45-degree field of view.
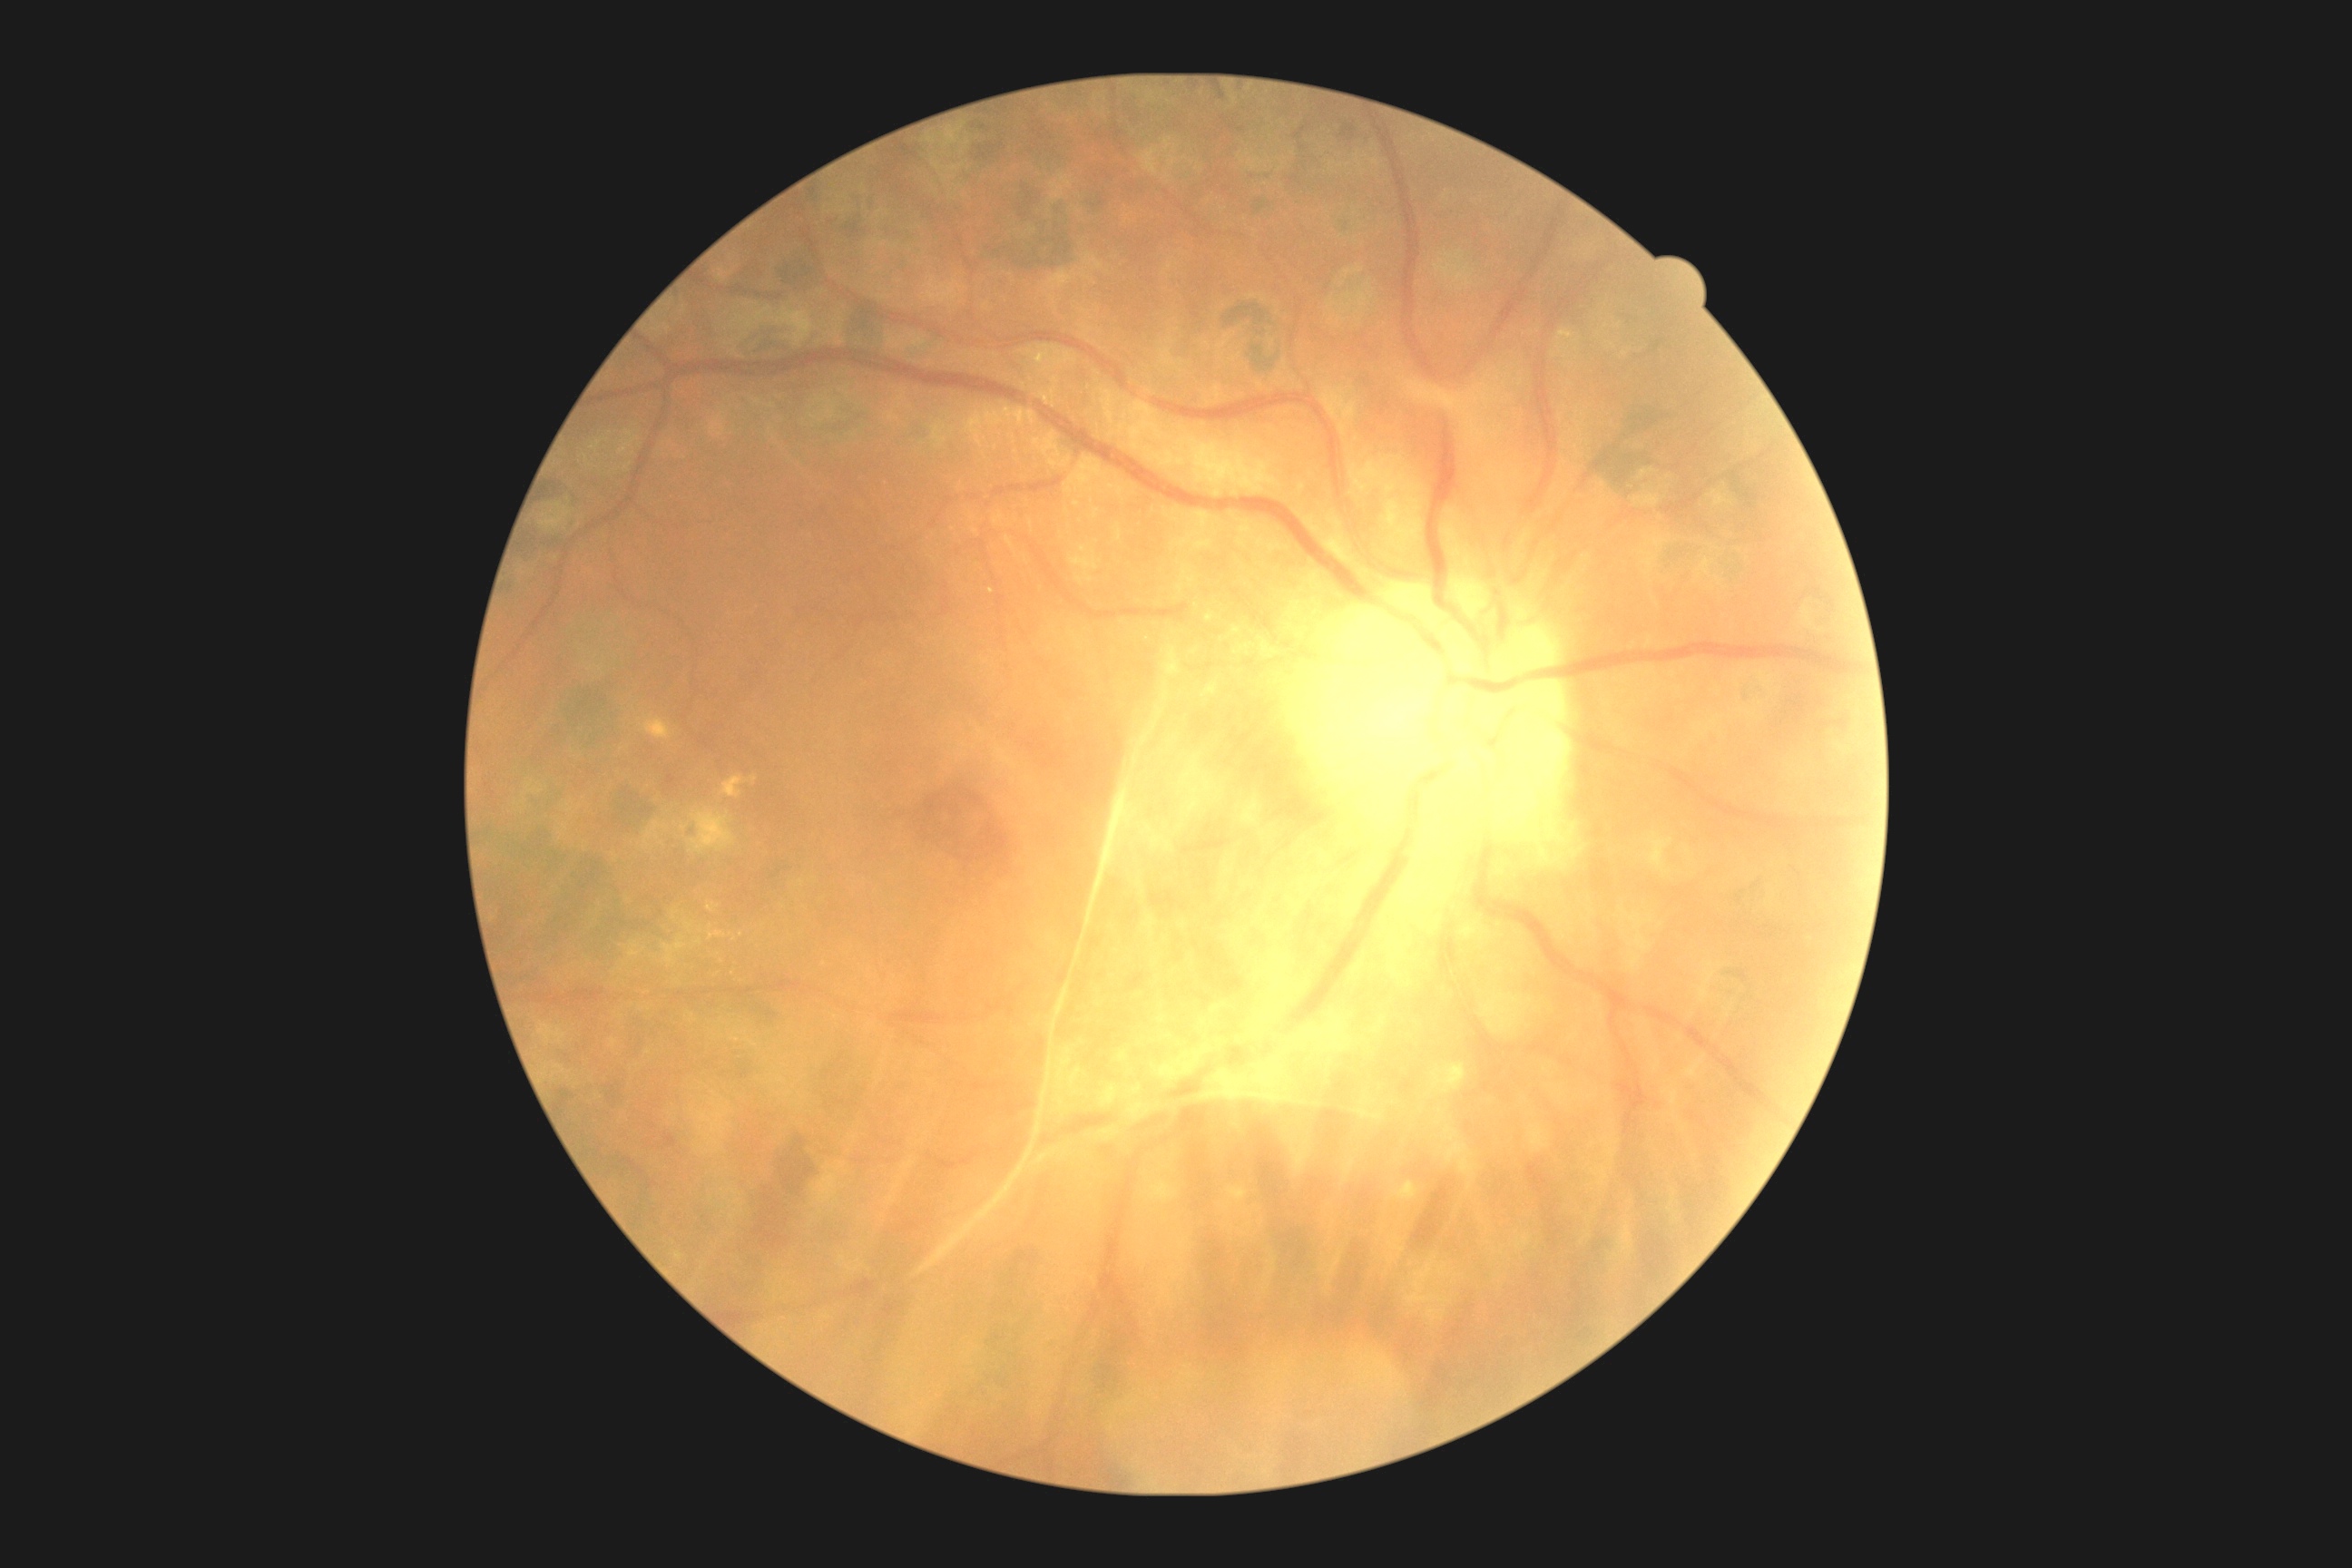

Diabetic retinopathy (DR): grade 4 (PDR).